130° field of view (Natus RetCam Envision). Pediatric wide-field fundus photograph: 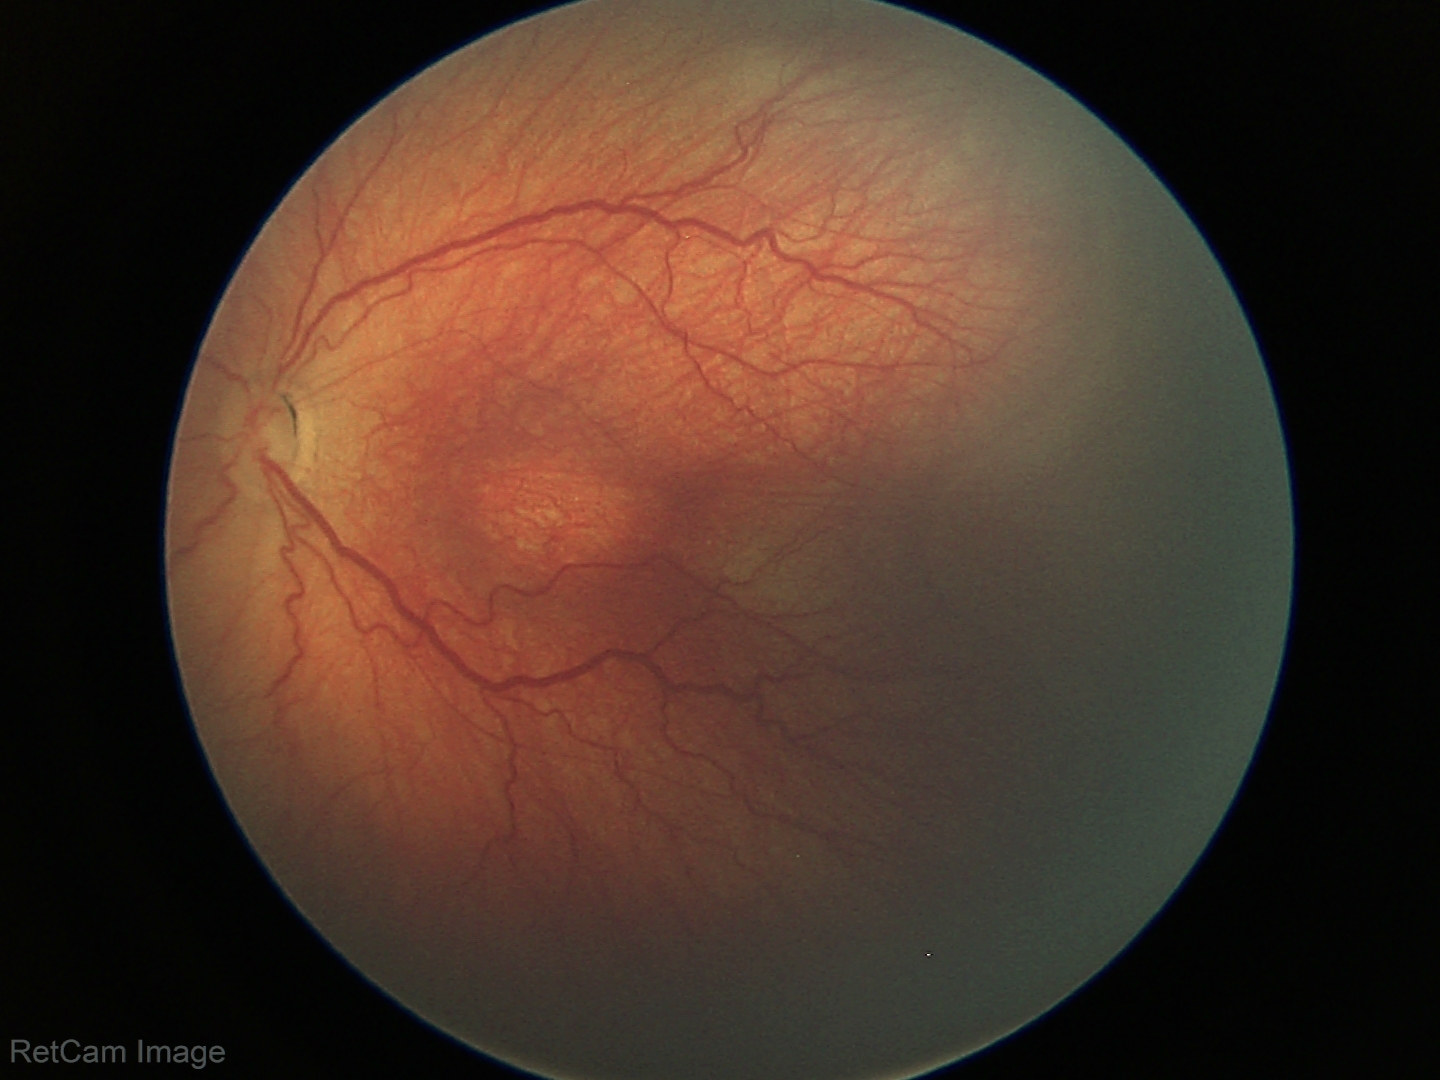 No plus disease. From an examination with diagnosis of retinopathy of prematurity (ROP) stage 3.